Captured after pupil dilation. Camera: Topcon TRC-50DX: 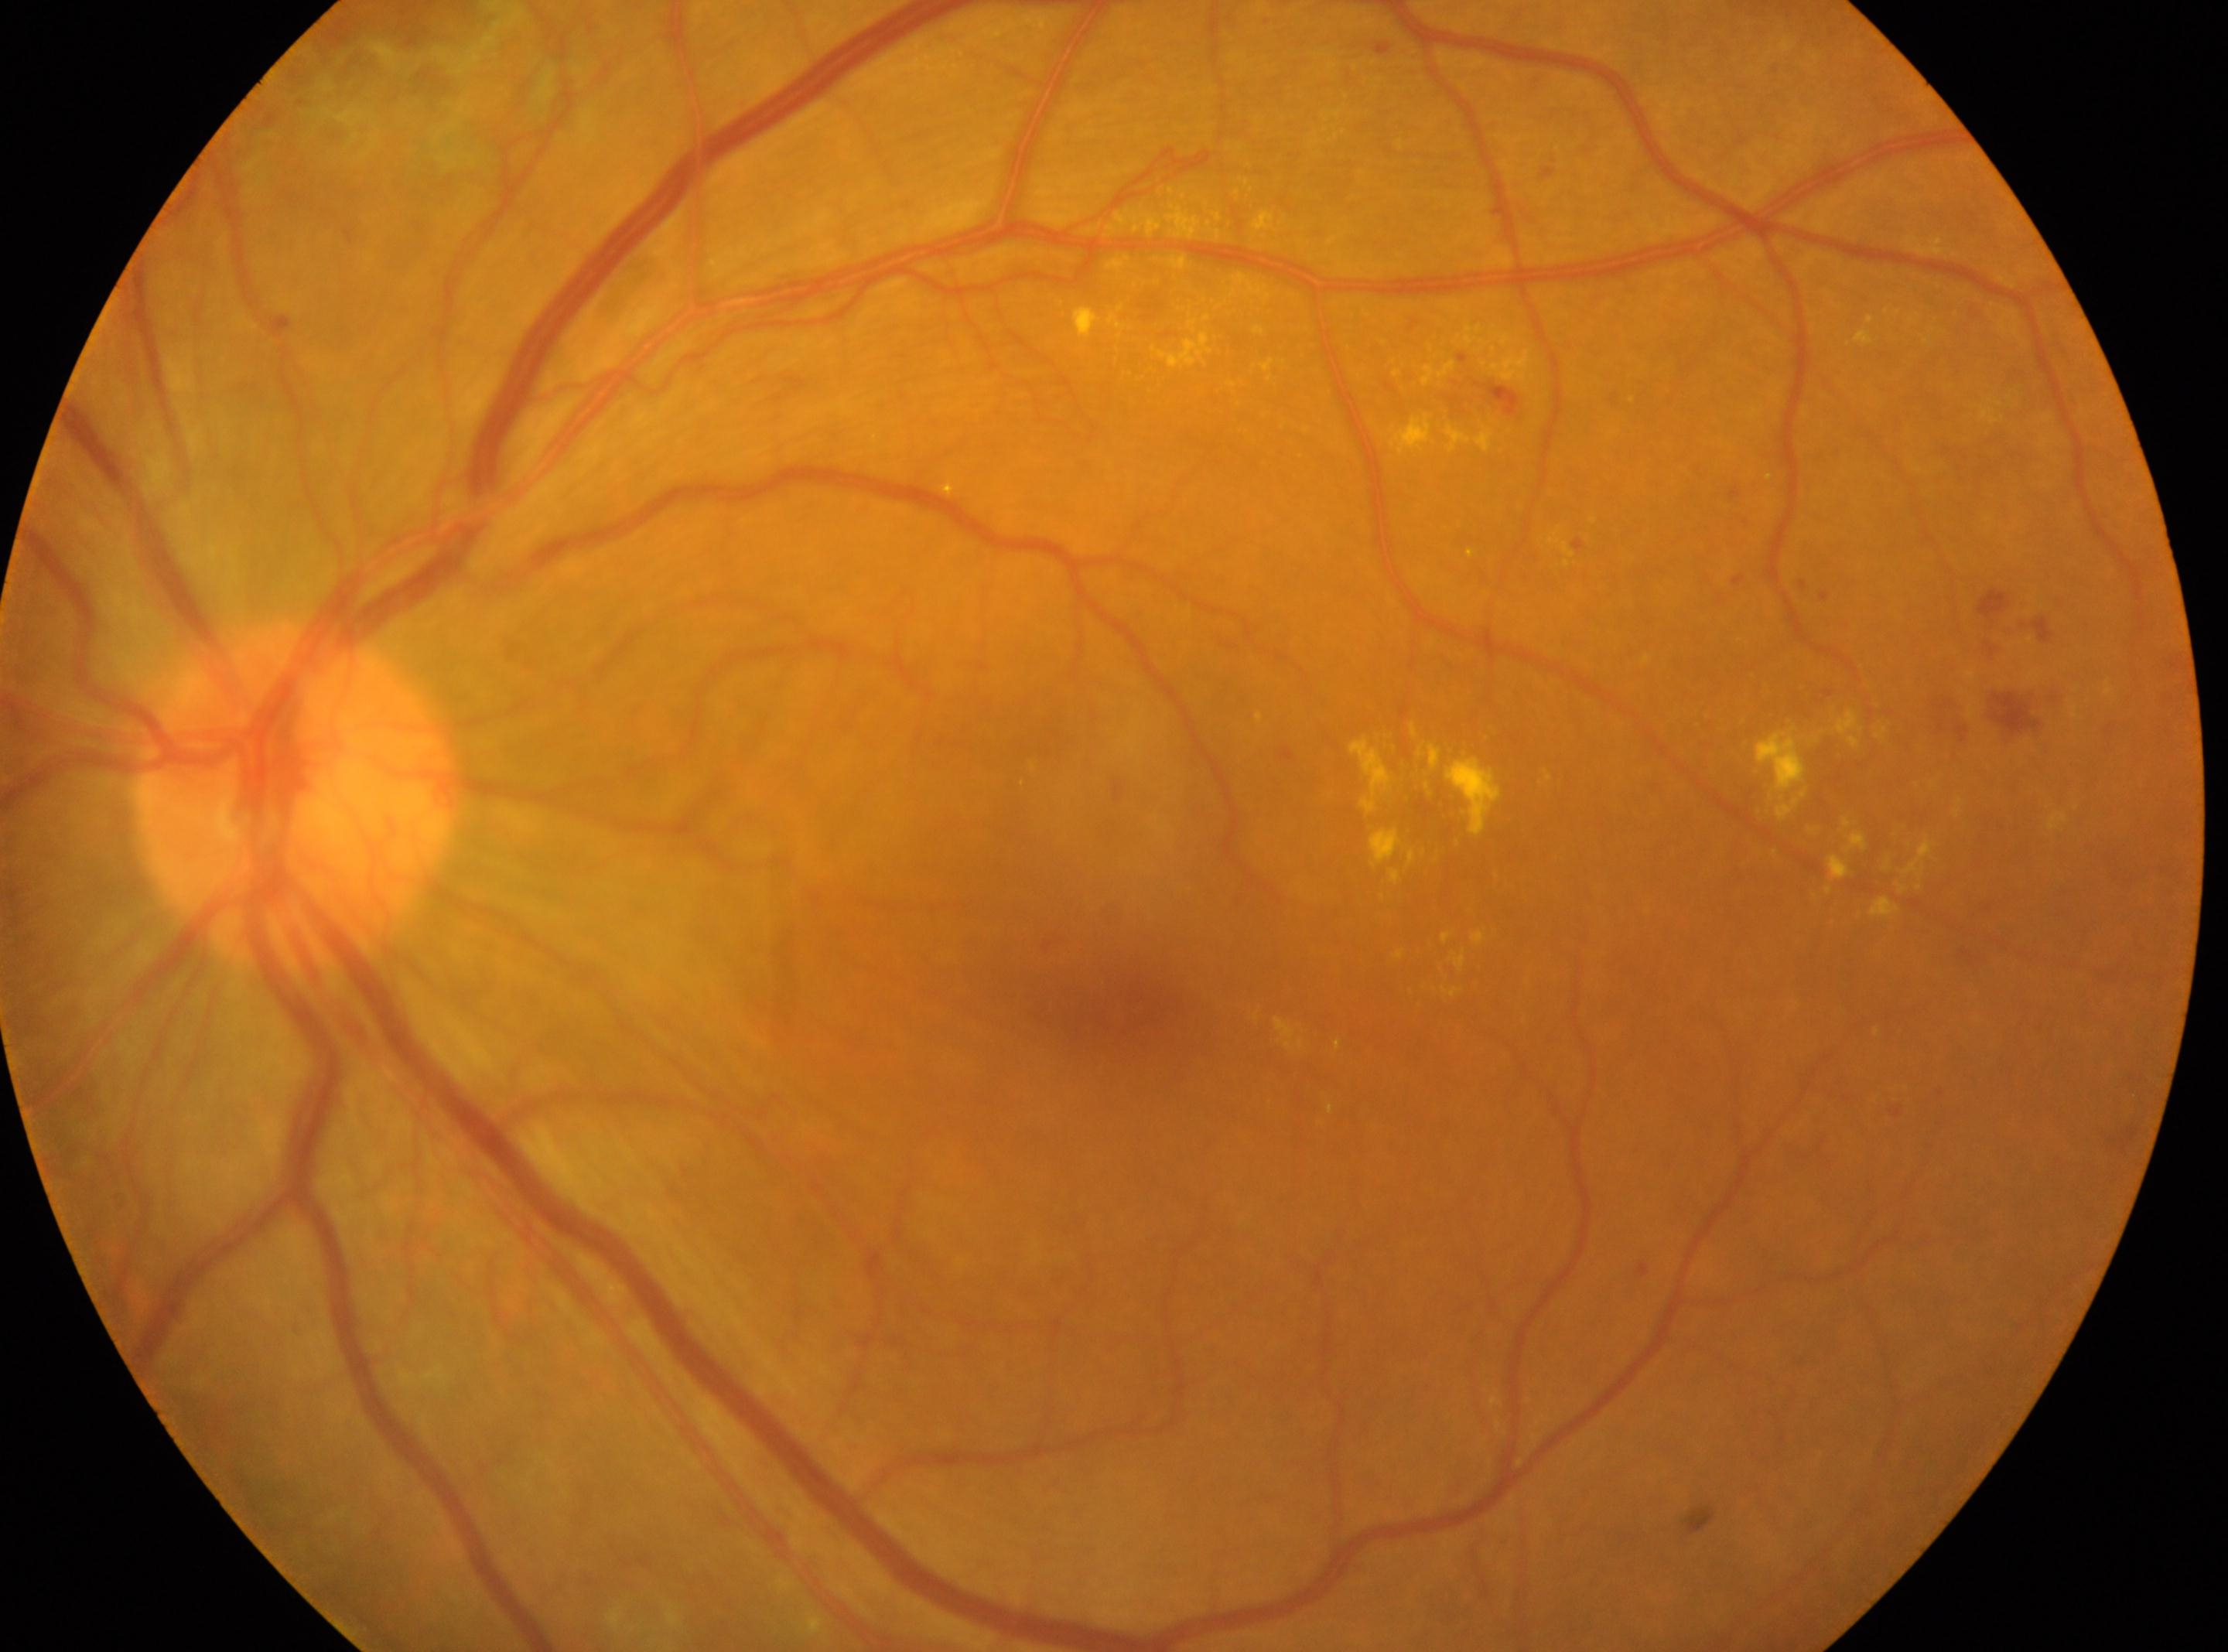 DR stage: post-laser DR, with underlying proliferative diabetic retinopathy (grade 4). This is the left eye. Macular center located at x=1117, y=1007. The optic nerve head is at x=294, y=794.